Topcon TRC-50DX: 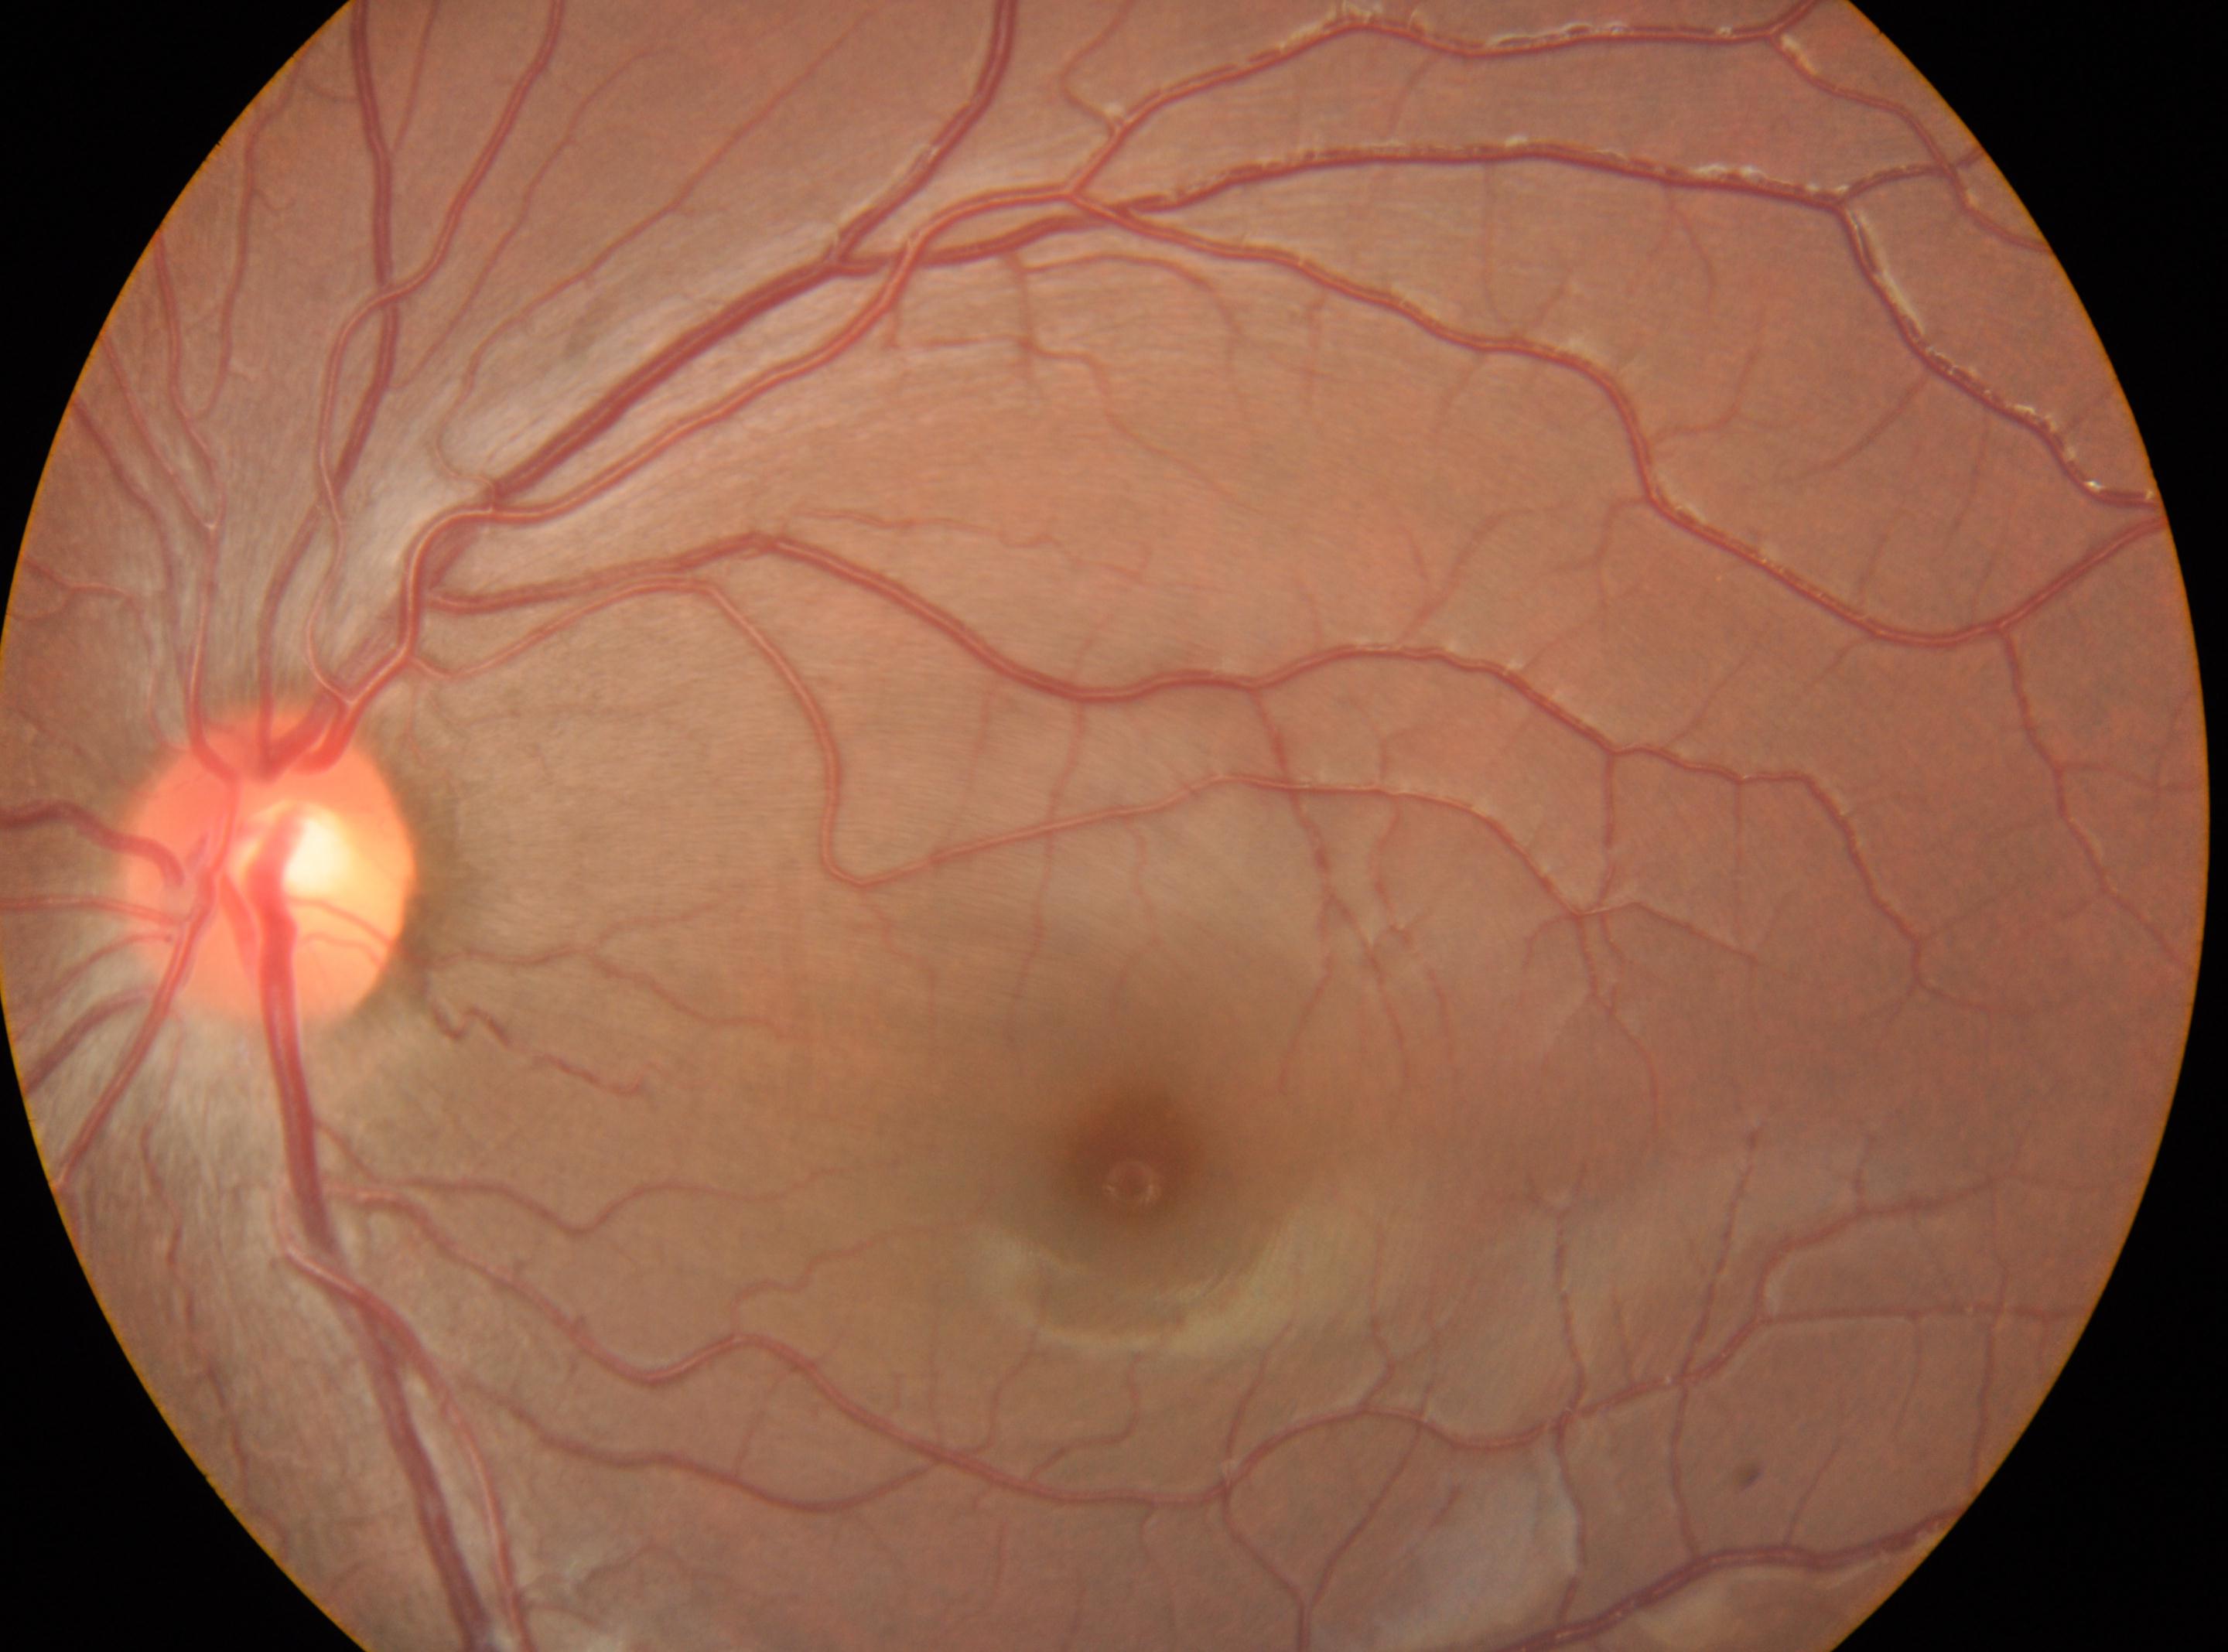

Annotations:
* macular center · (1129,1163)
* retinopathy · 0/4
* disc center · (268,869)
* laterality · left